45° FOV. Color fundus photograph
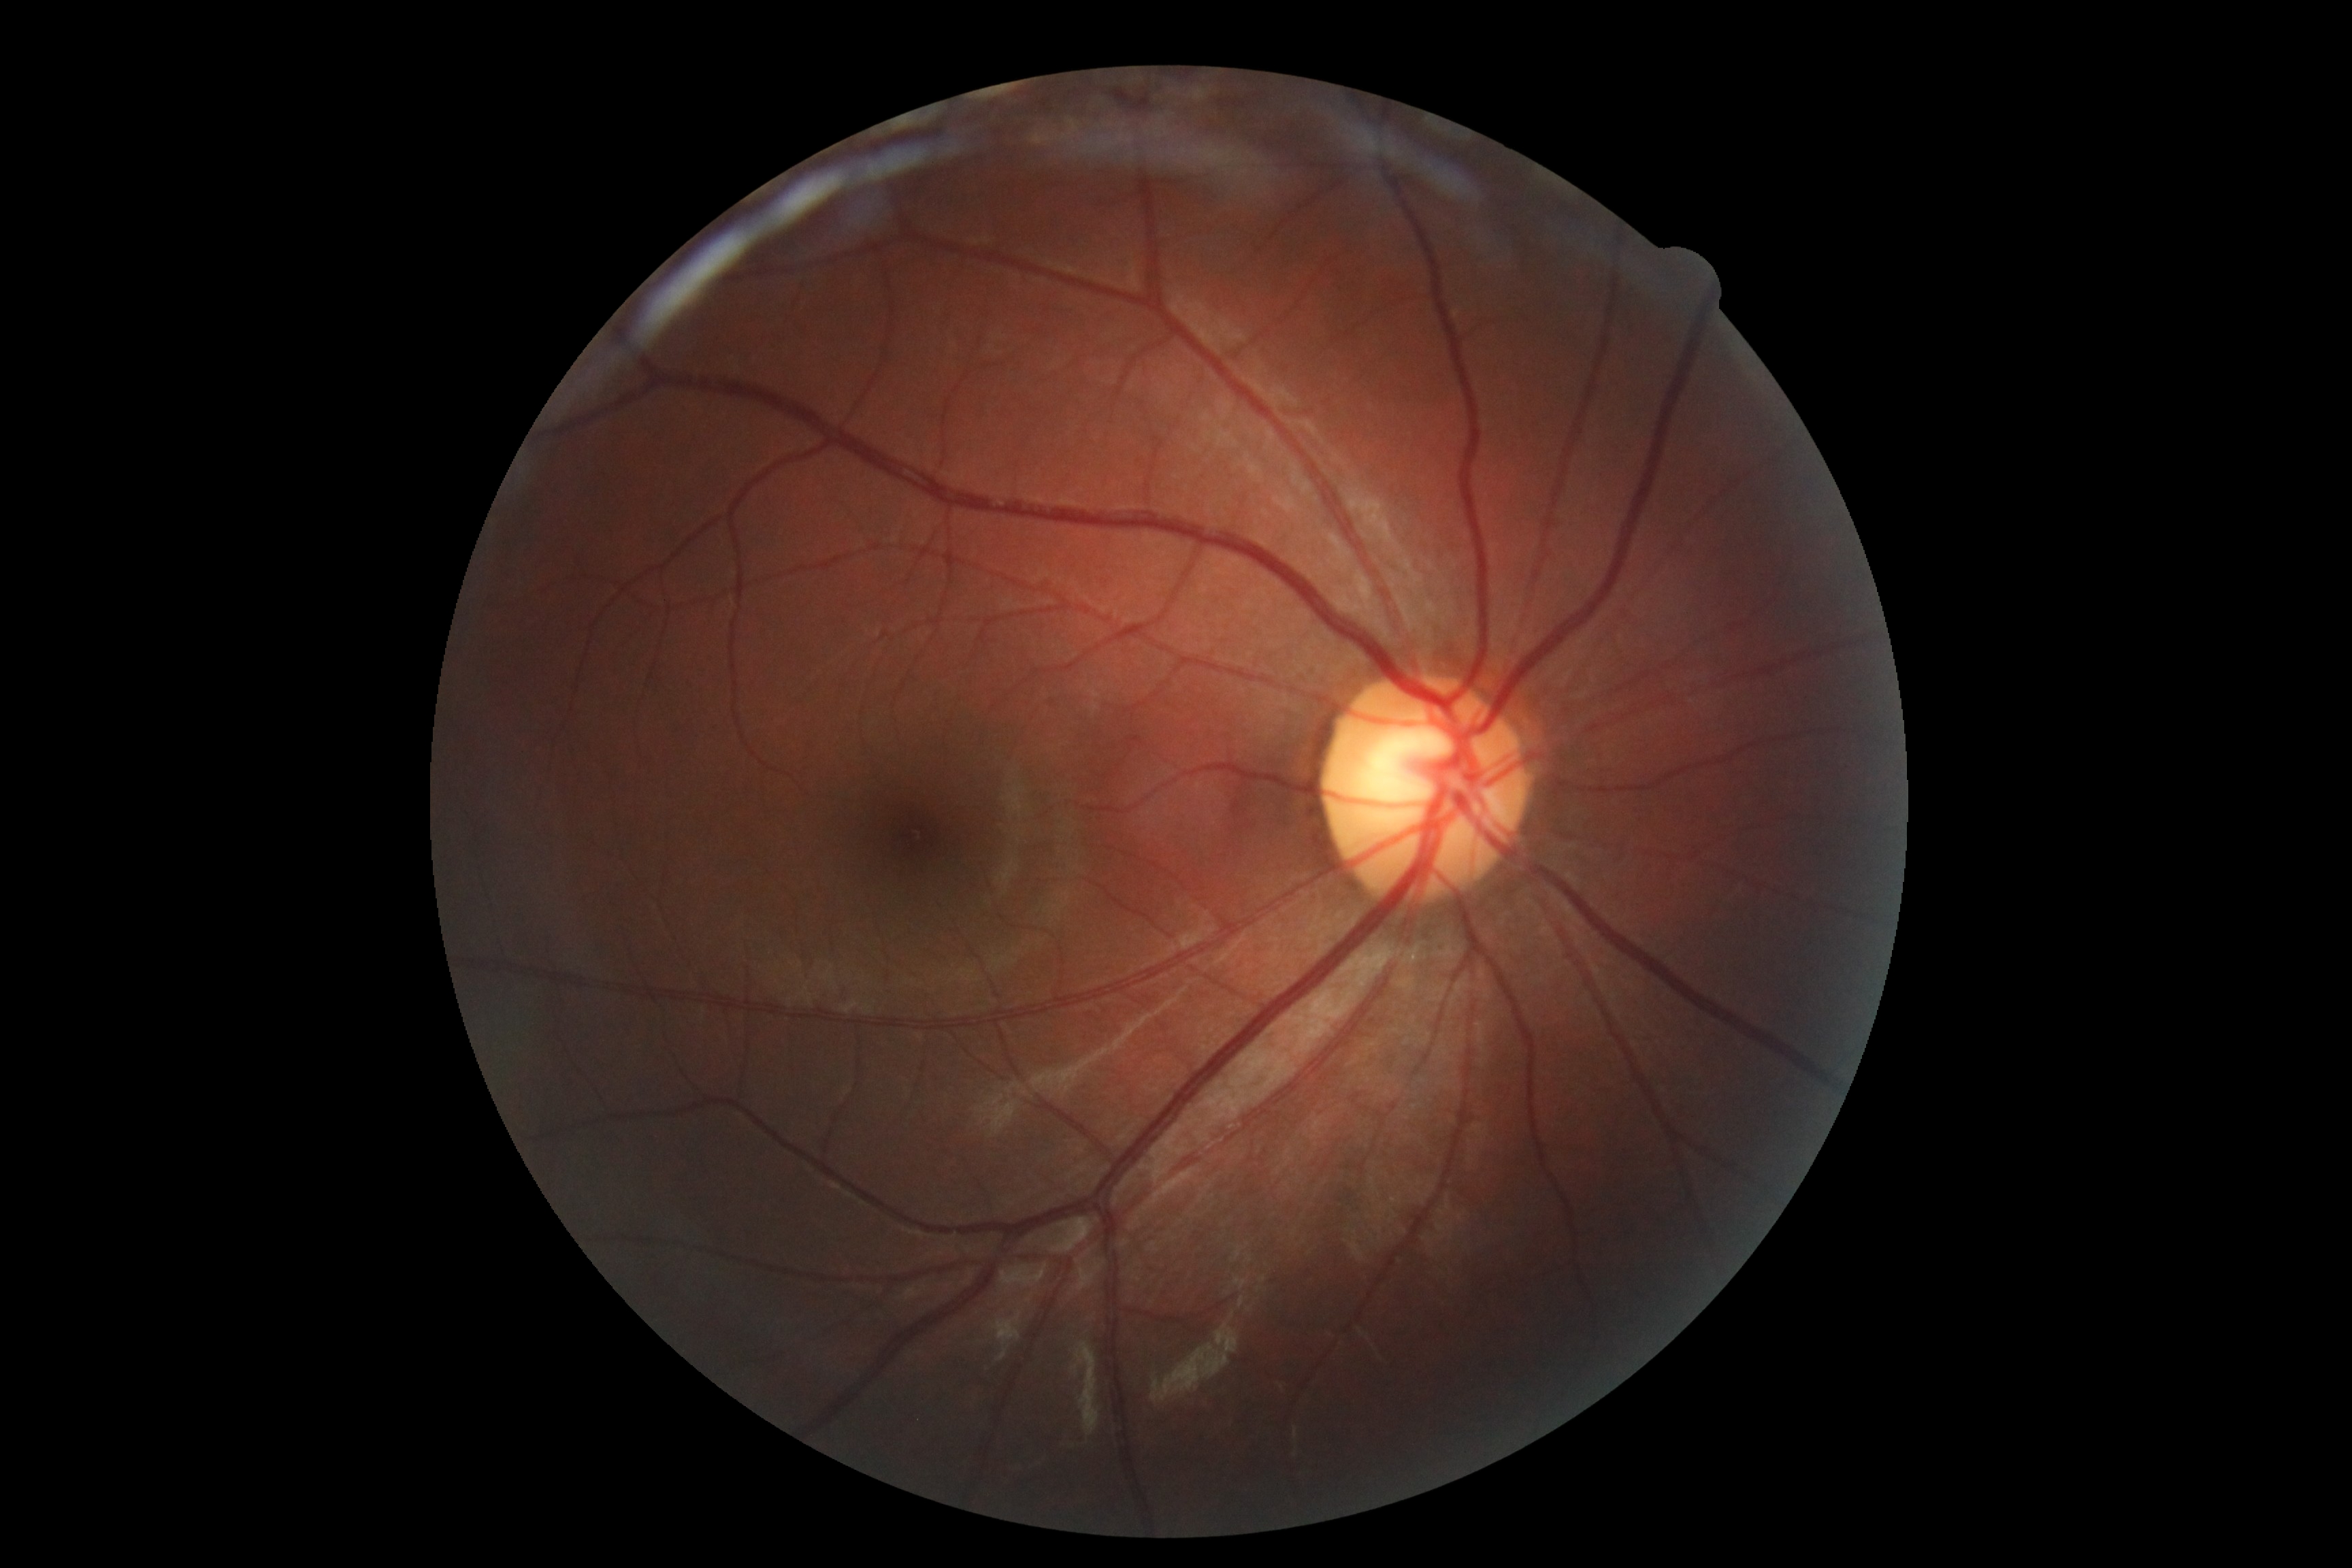

DR: grade 0 (no apparent retinopathy) | DR impression: no DR findings.